Ultra-widefield fundus mosaic — 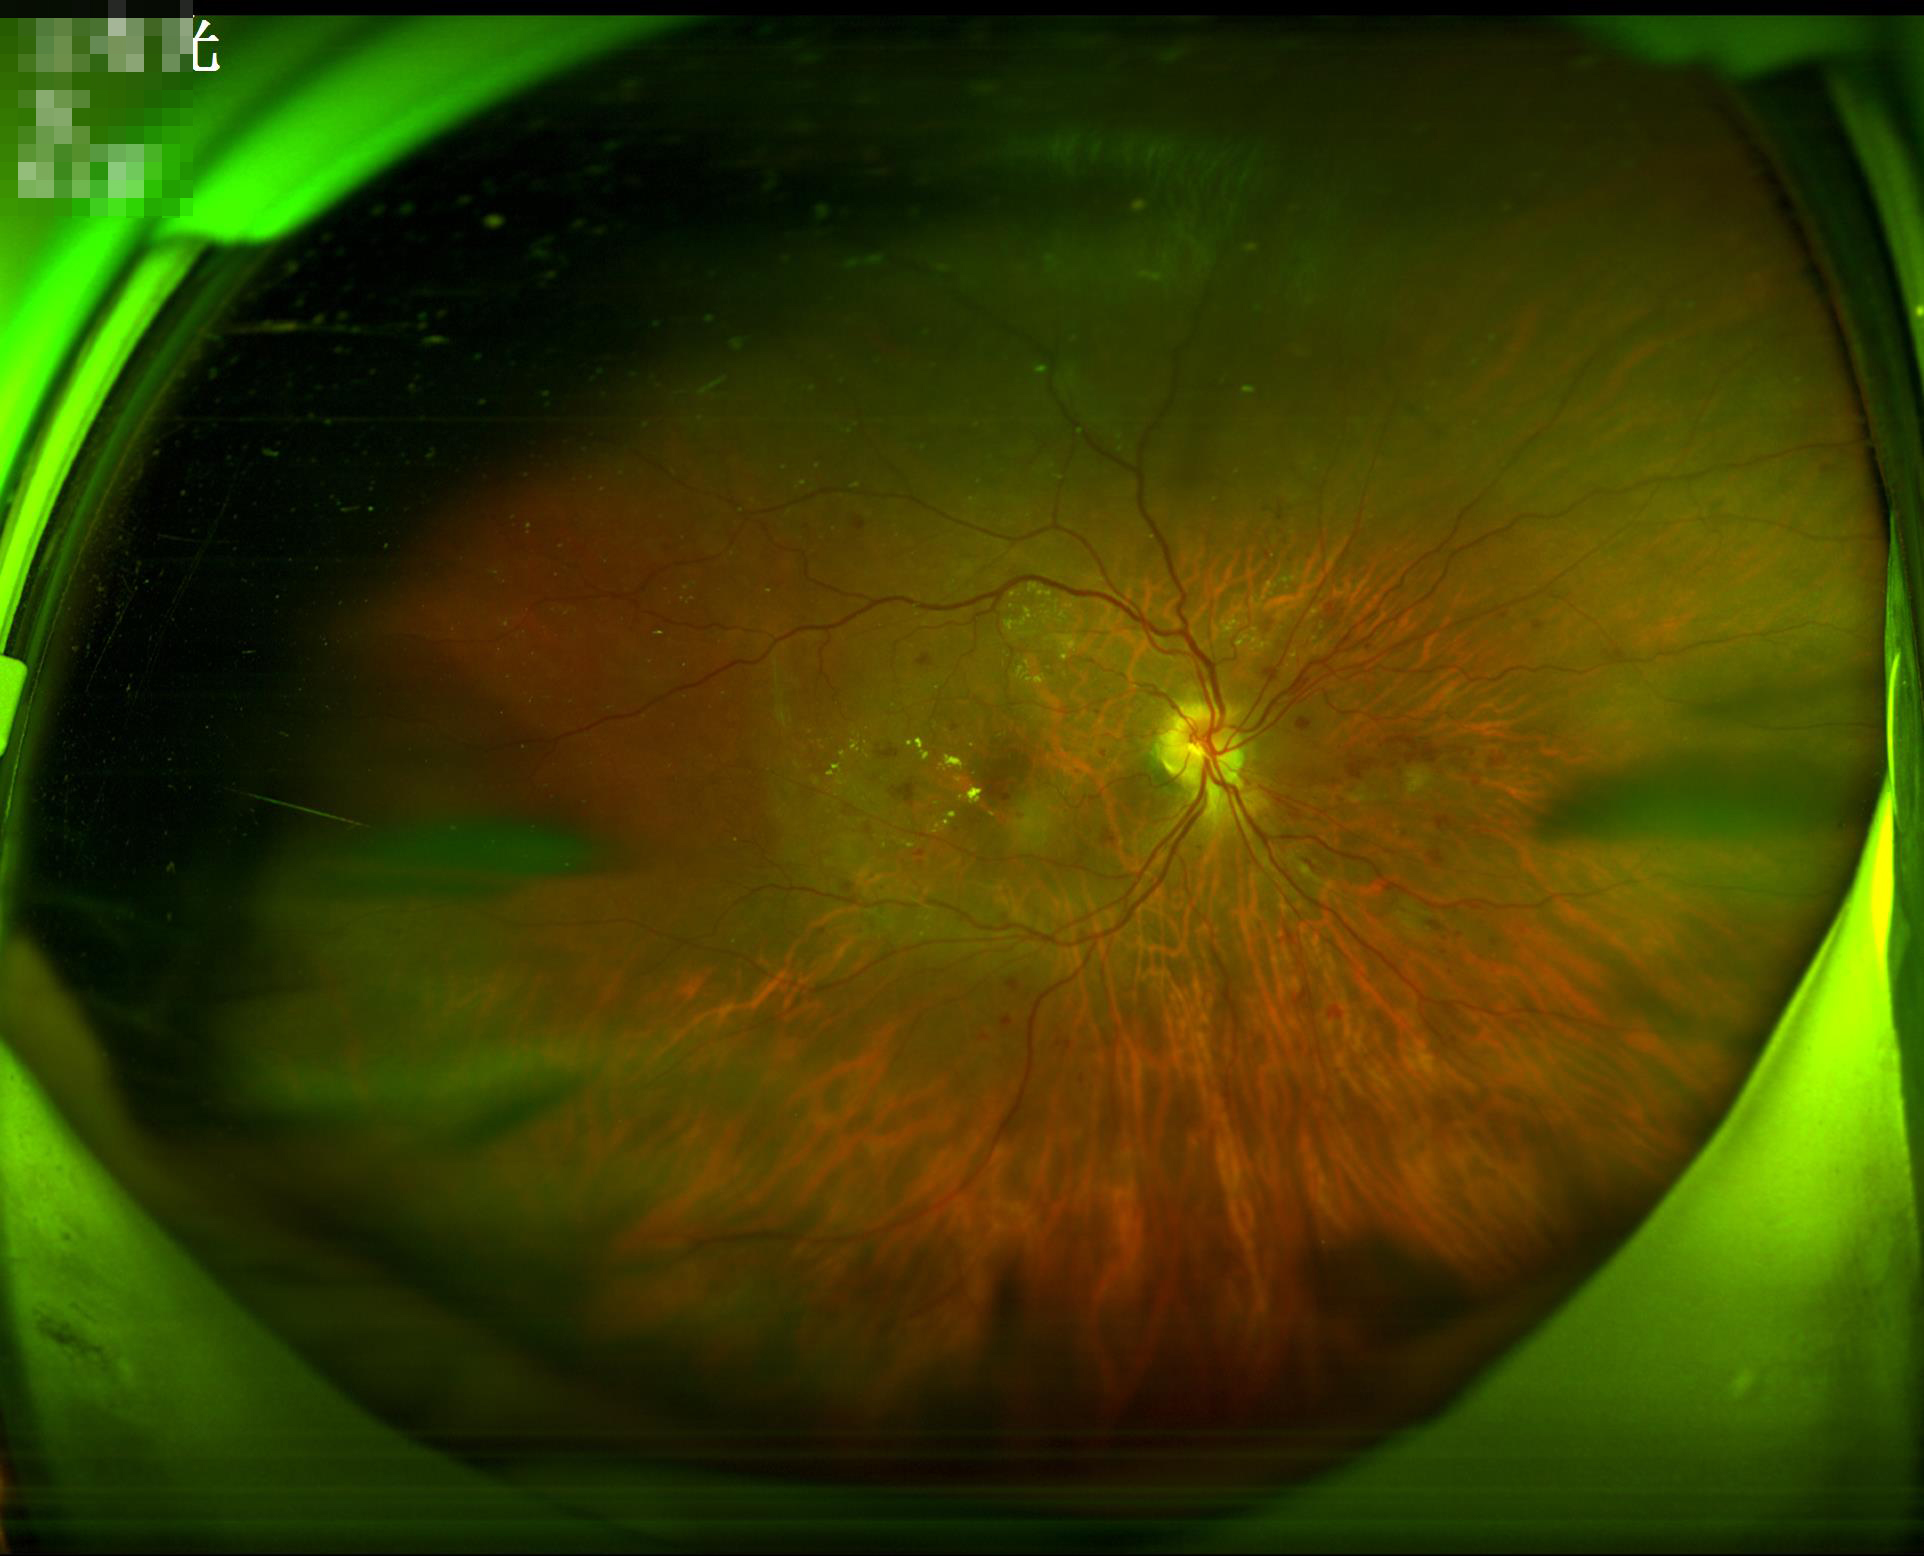
Illumination = uneven illumination or color cast; Overall = good, gradable; Clarity = sharp throughout the field; Contrast = good dynamic range.